FOV: 50 degrees:
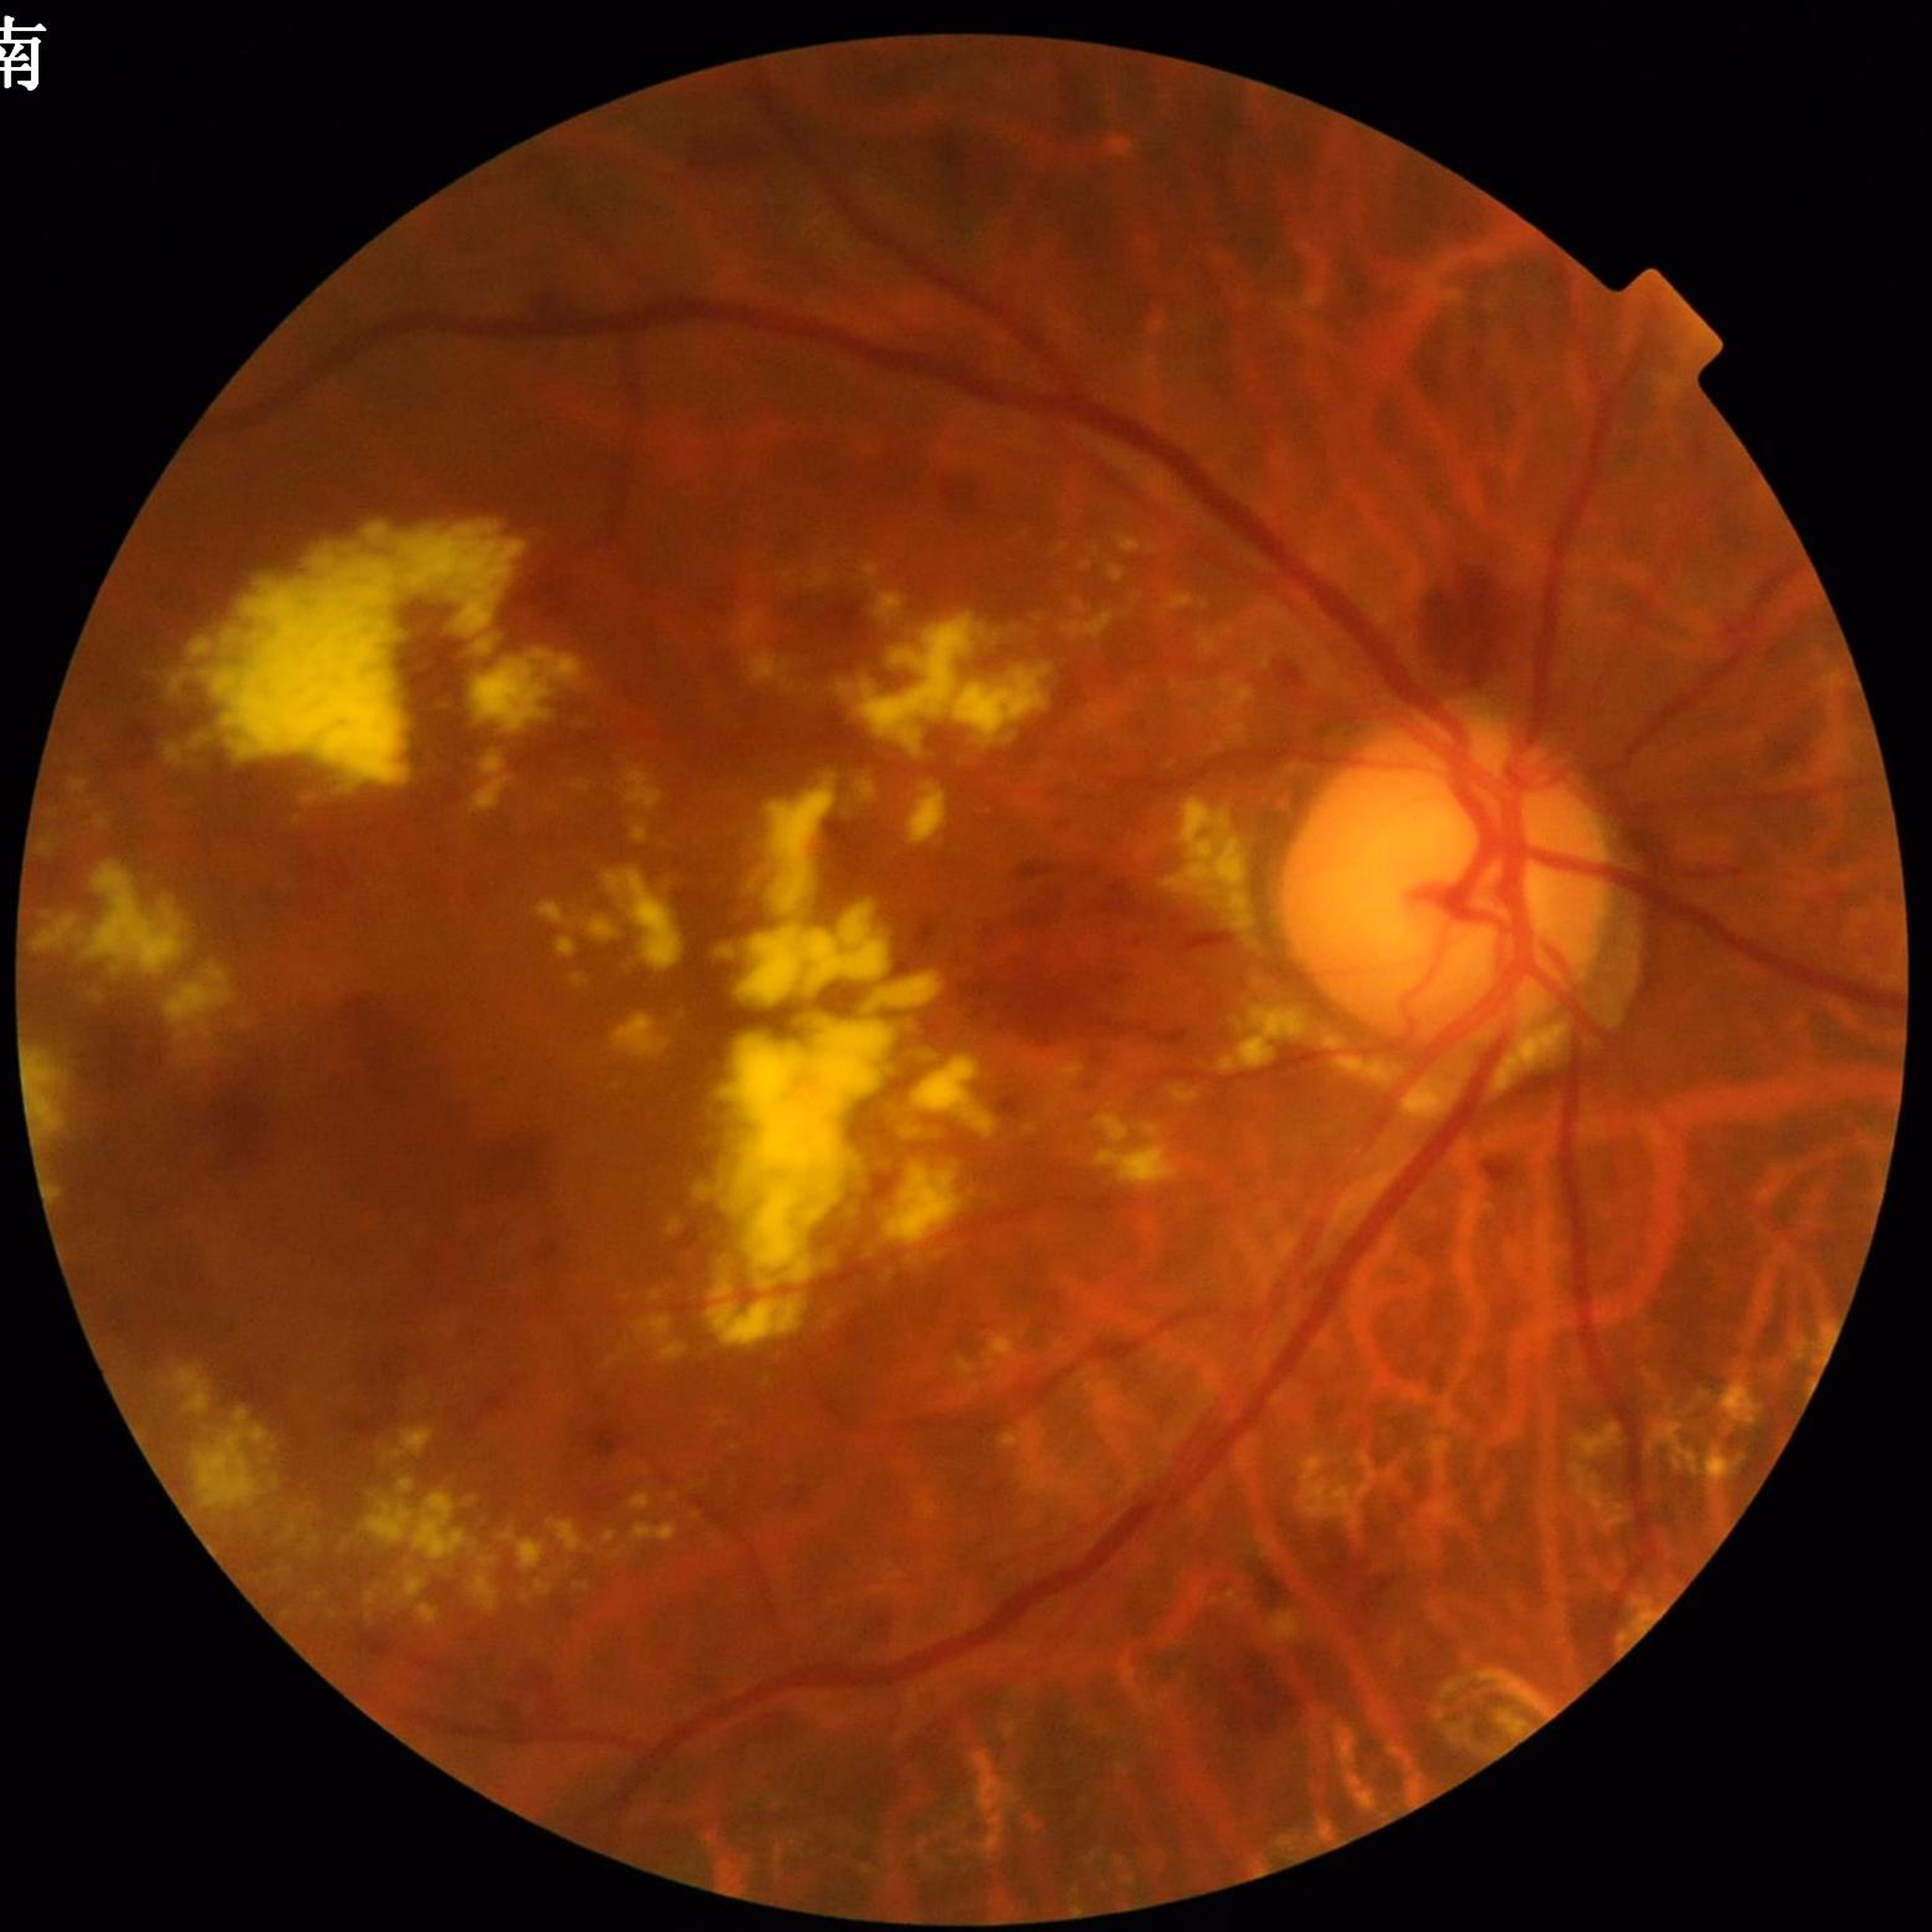
  diagnosis: diabetic retinopathy